Image size 2352x1568: 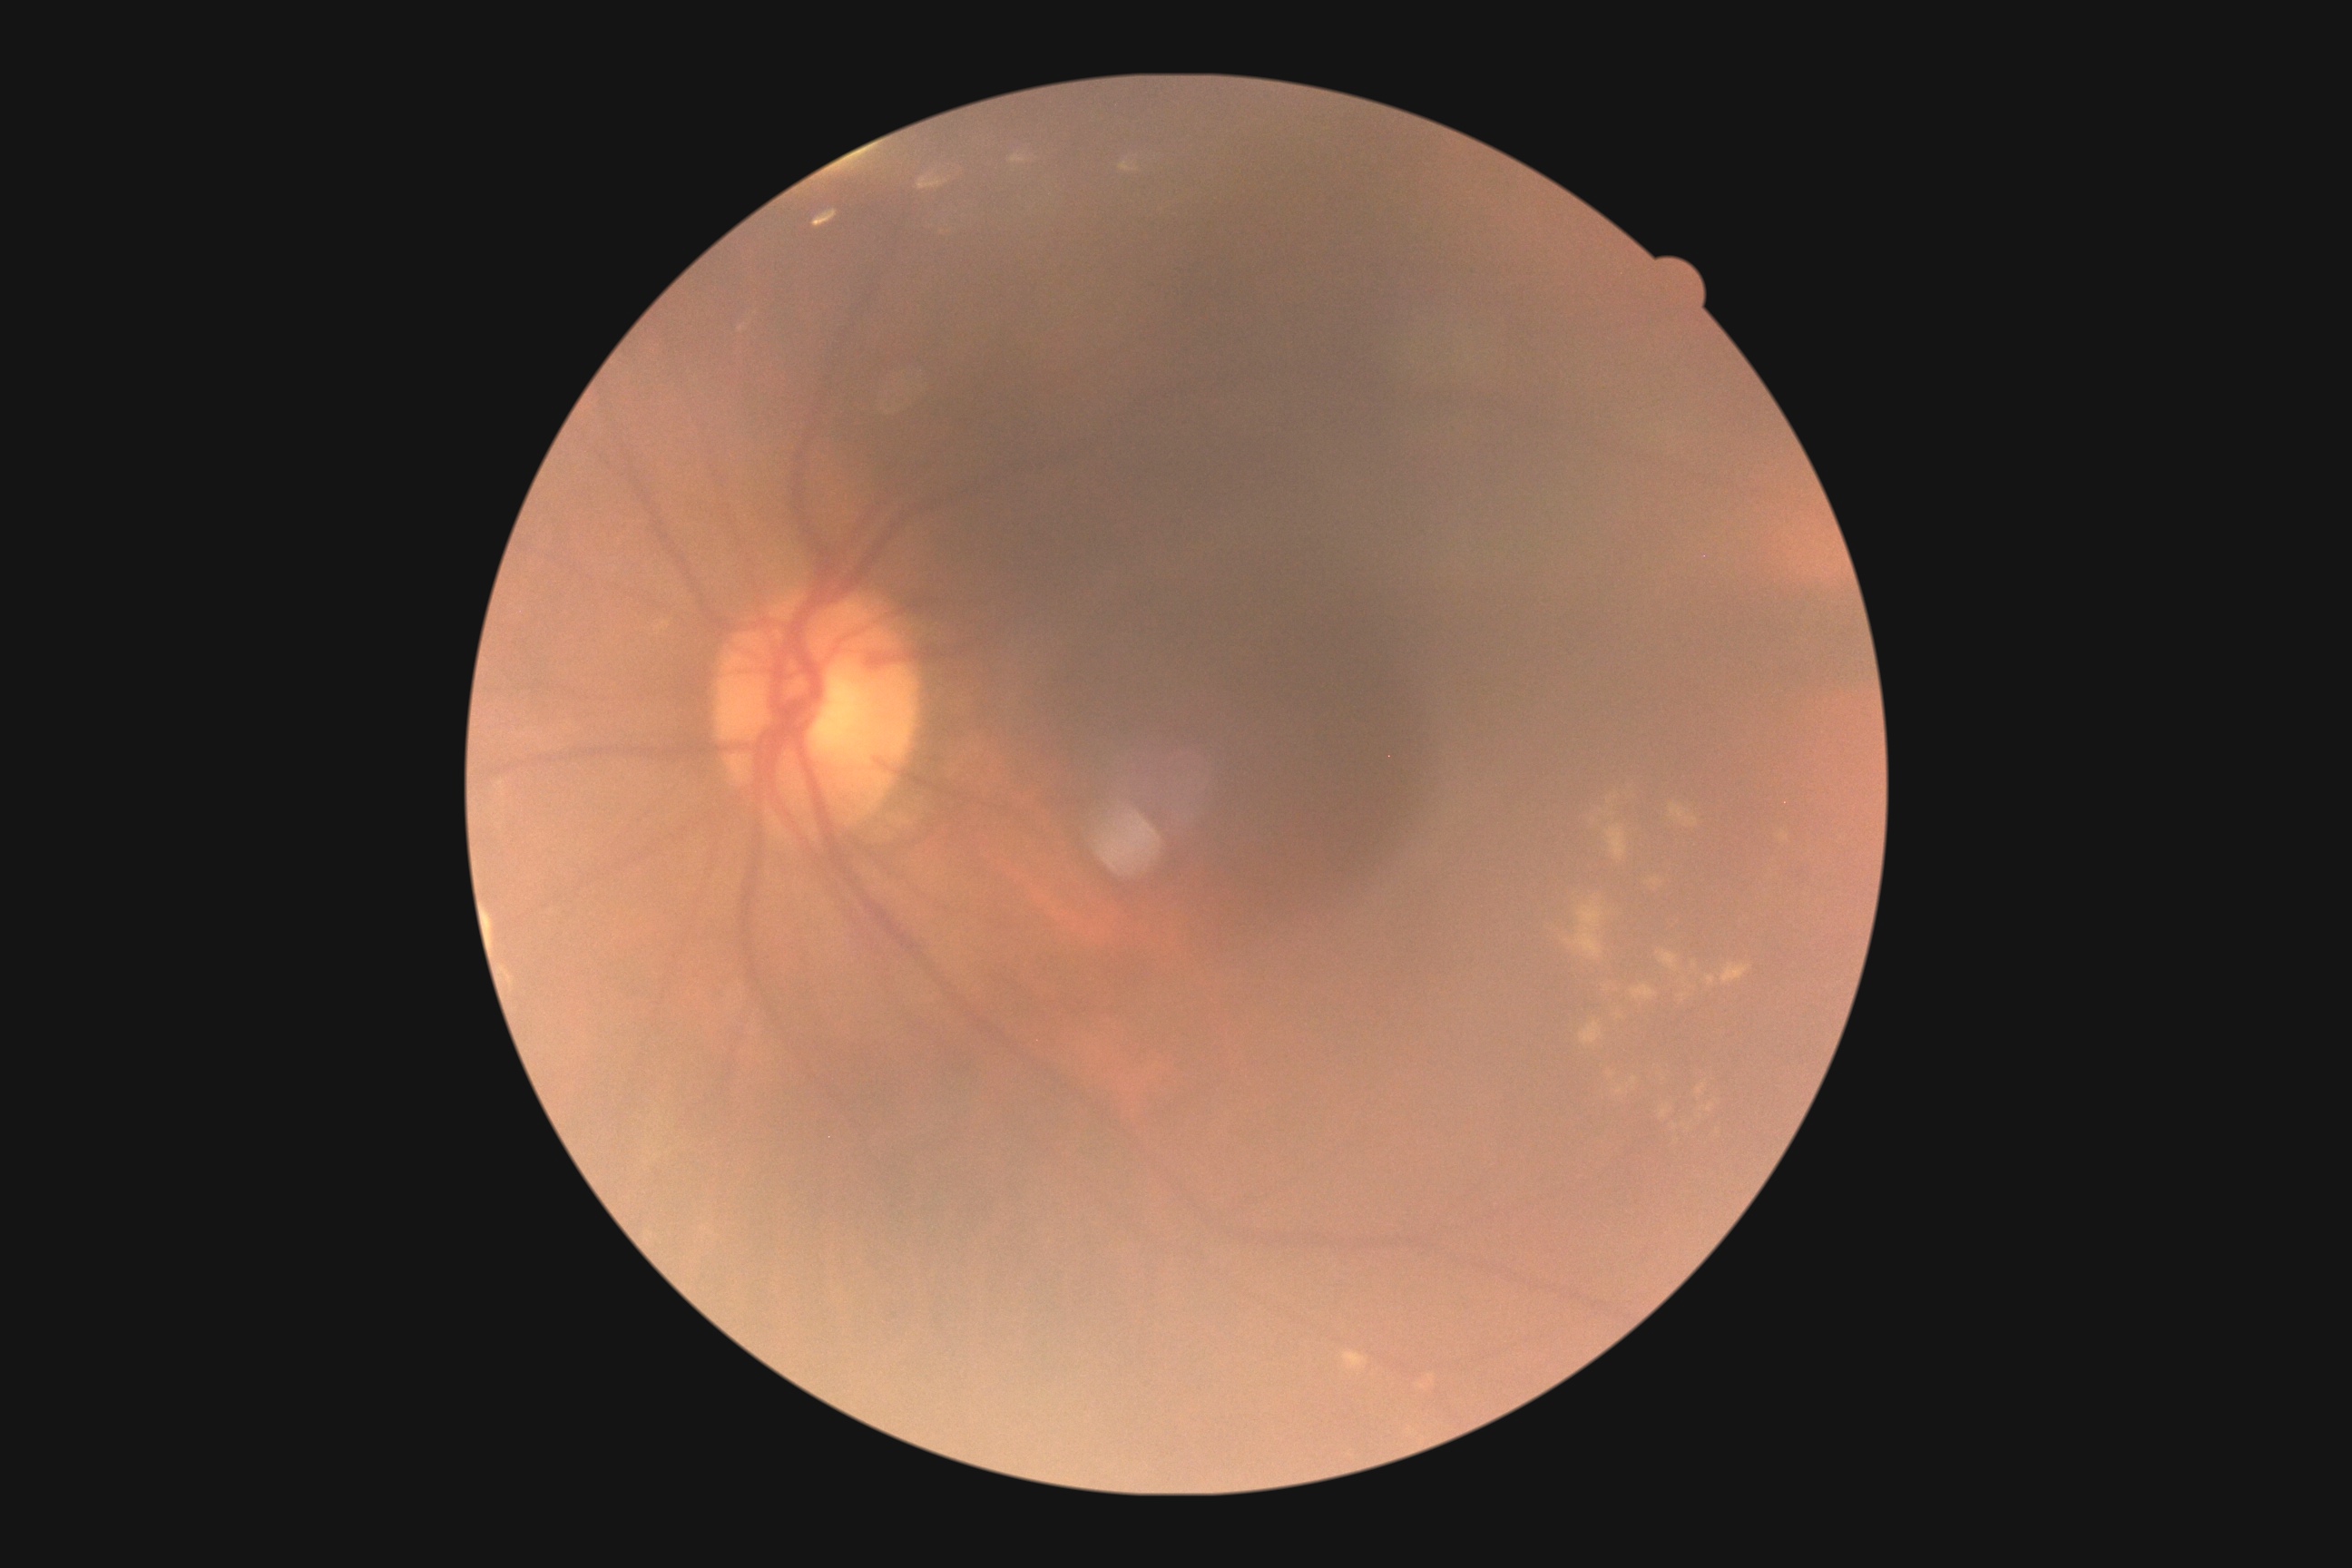
Diabetic retinopathy severity: moderate NPDR (grade 2).